45° FOV; modified Davis classification: 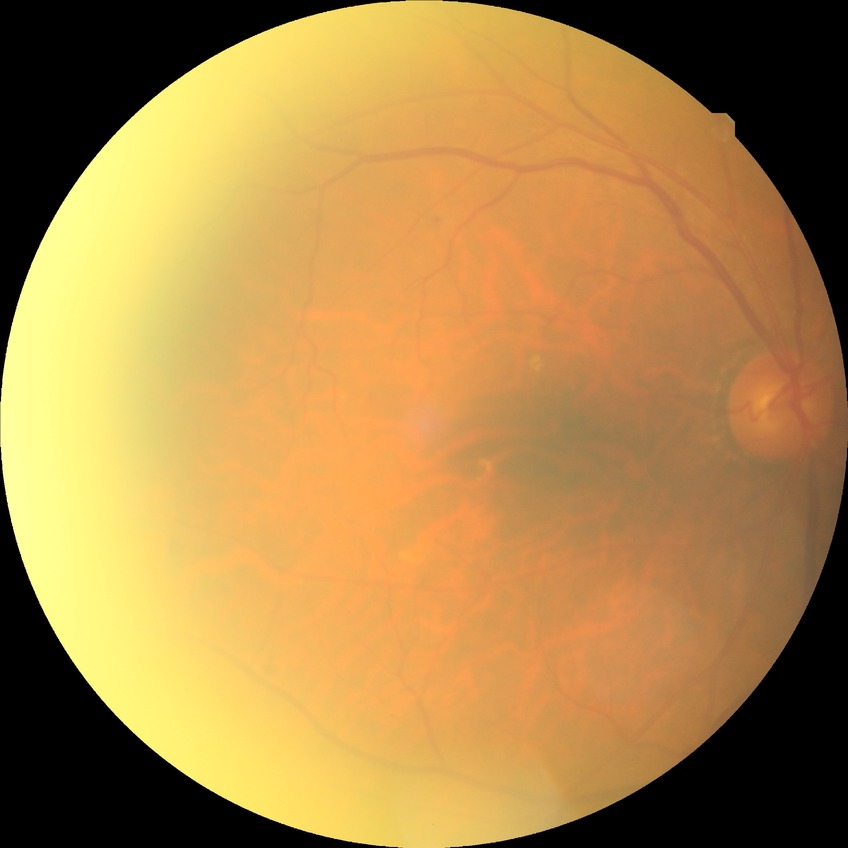

  proliferative_class: non-proliferative diabetic retinopathy
  davis_grade: simple diabetic retinopathy